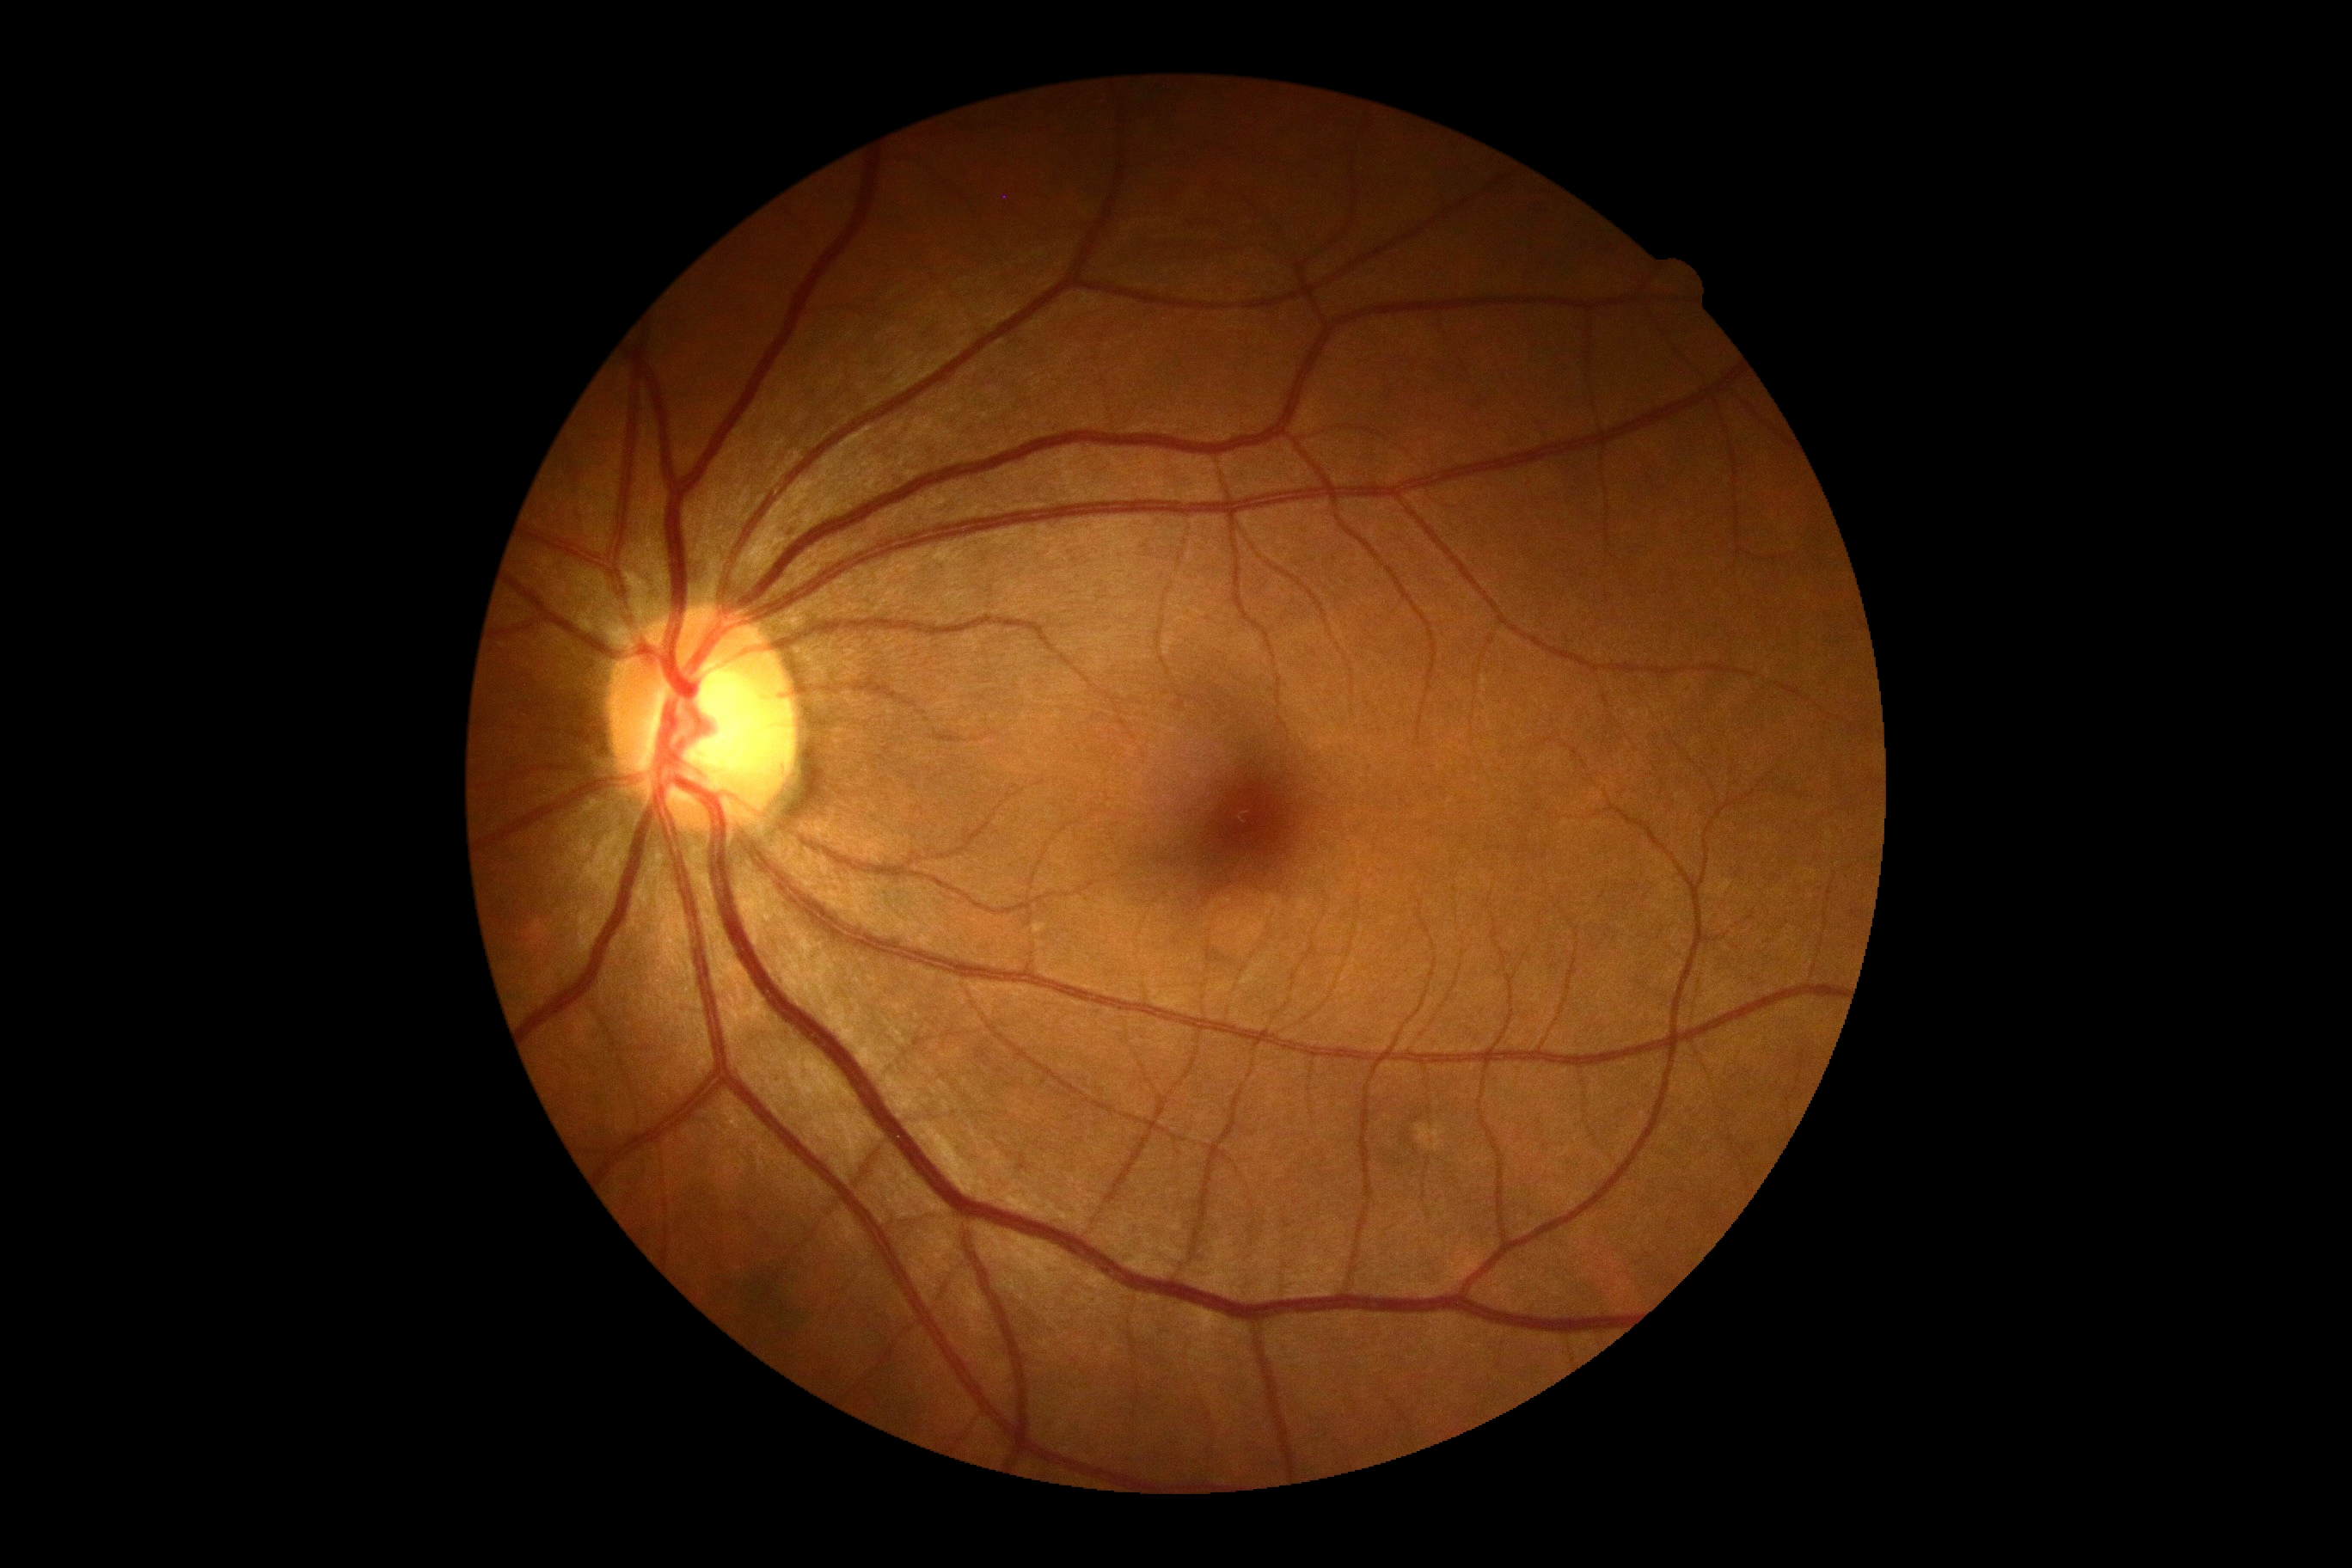
No diabetic retinal disease findings.
Diabetic retinopathy severity: 0/4.